2048x1536px: 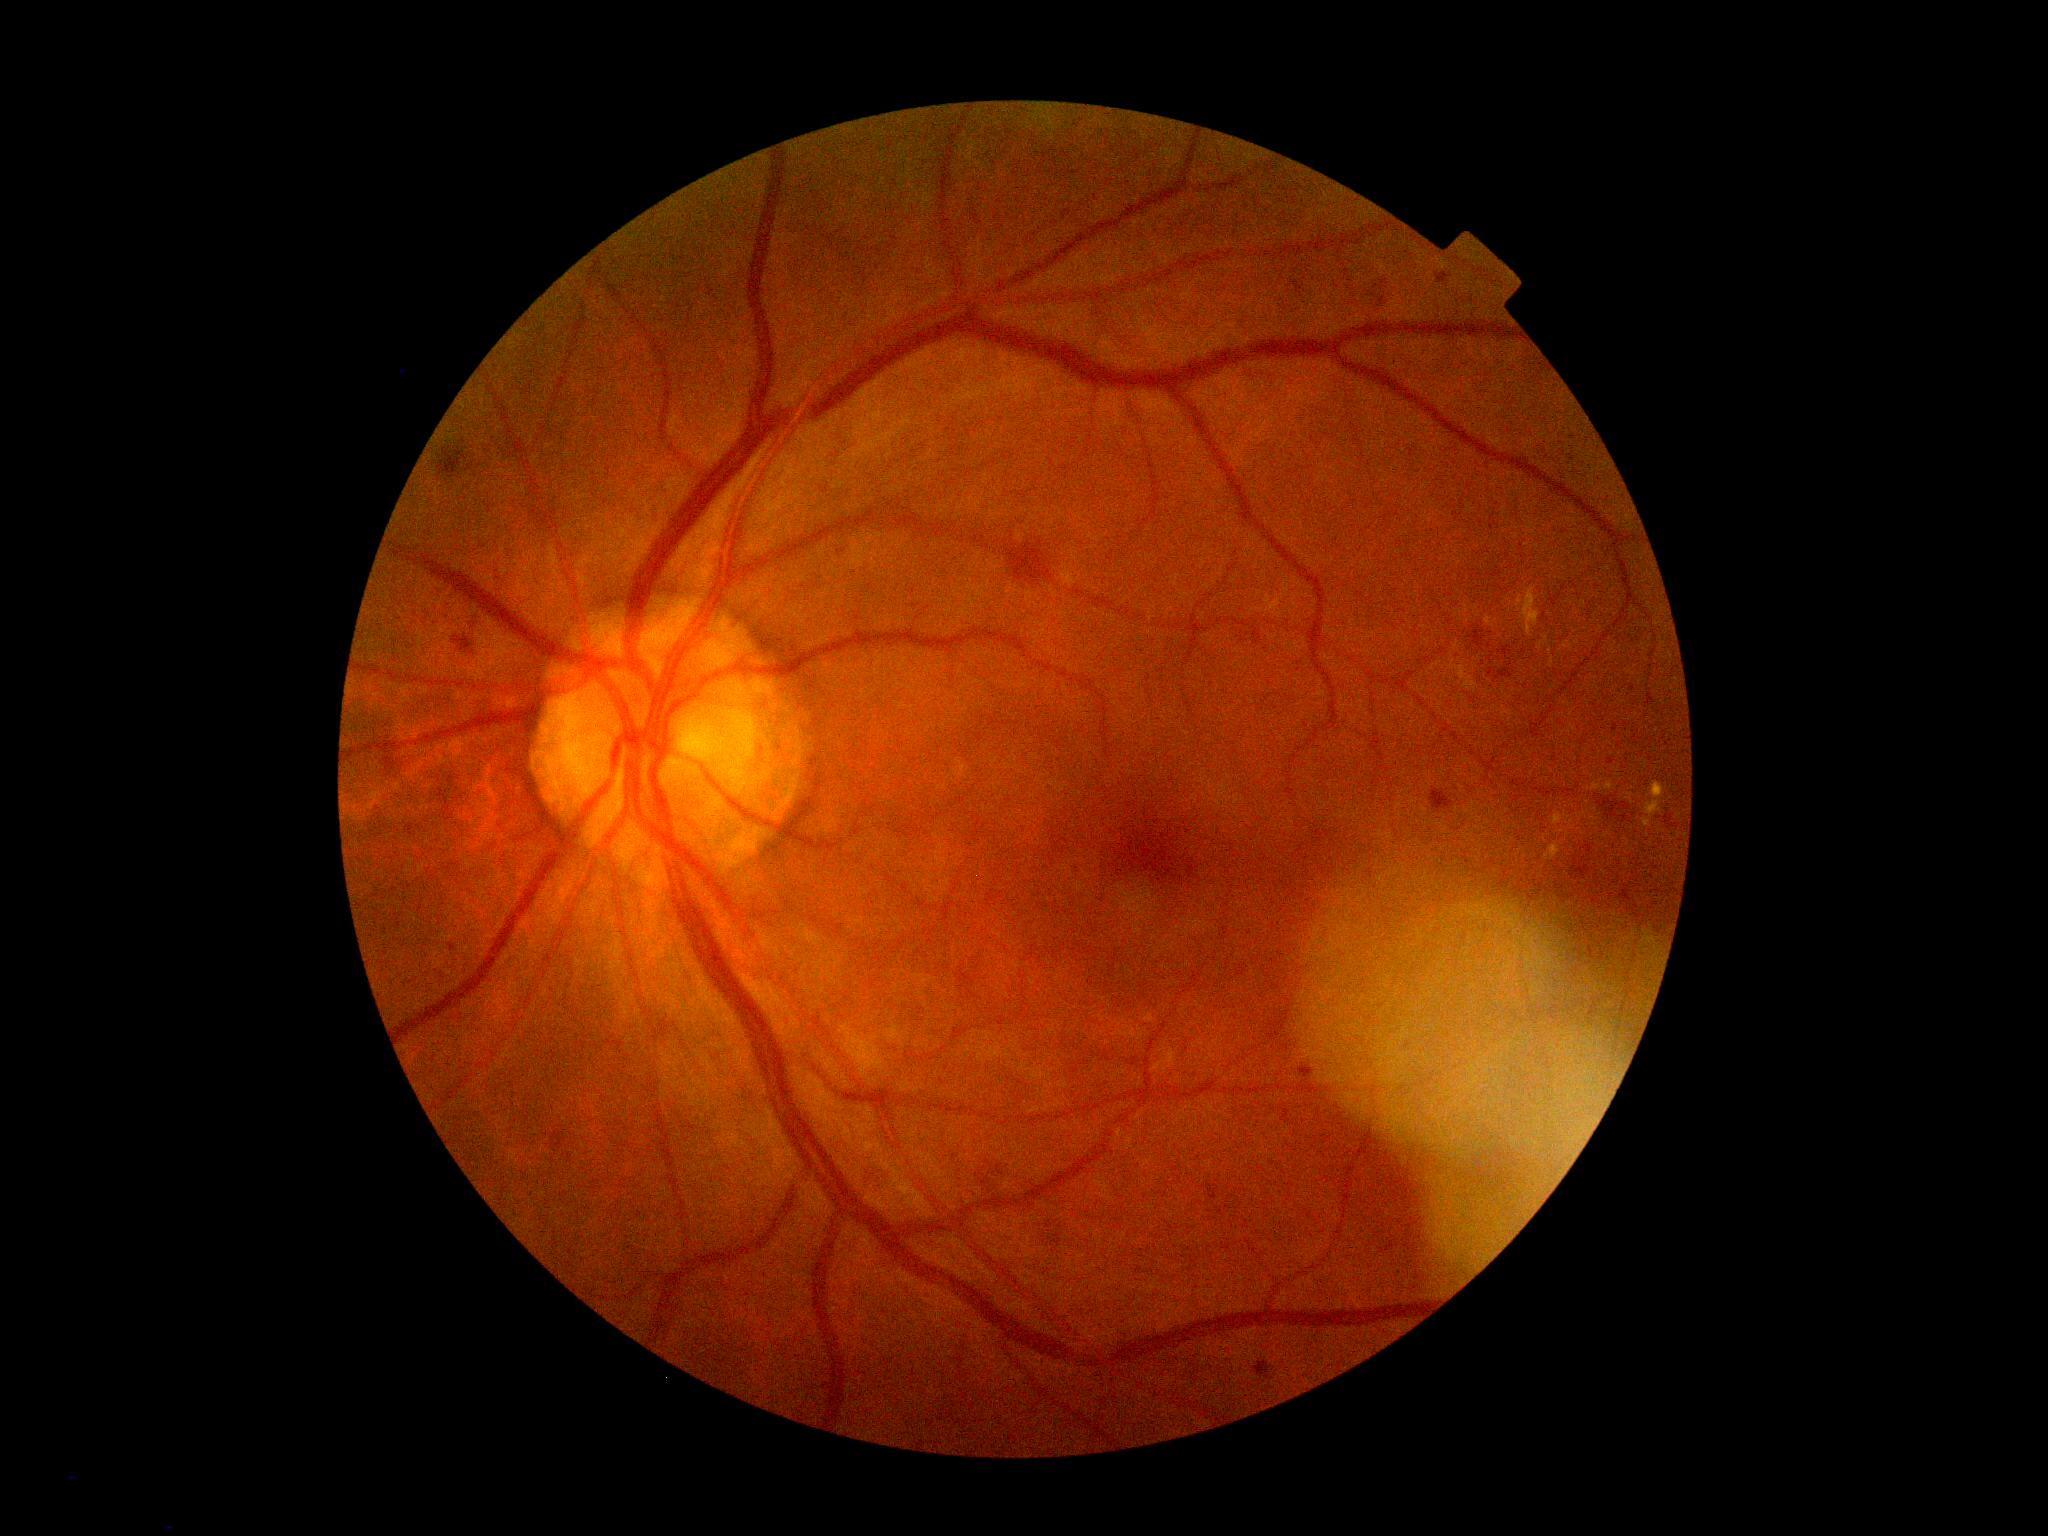 DR grade: 2/4.